1240 by 1240 pixels · wide-field fundus photograph from neonatal ROP screening.
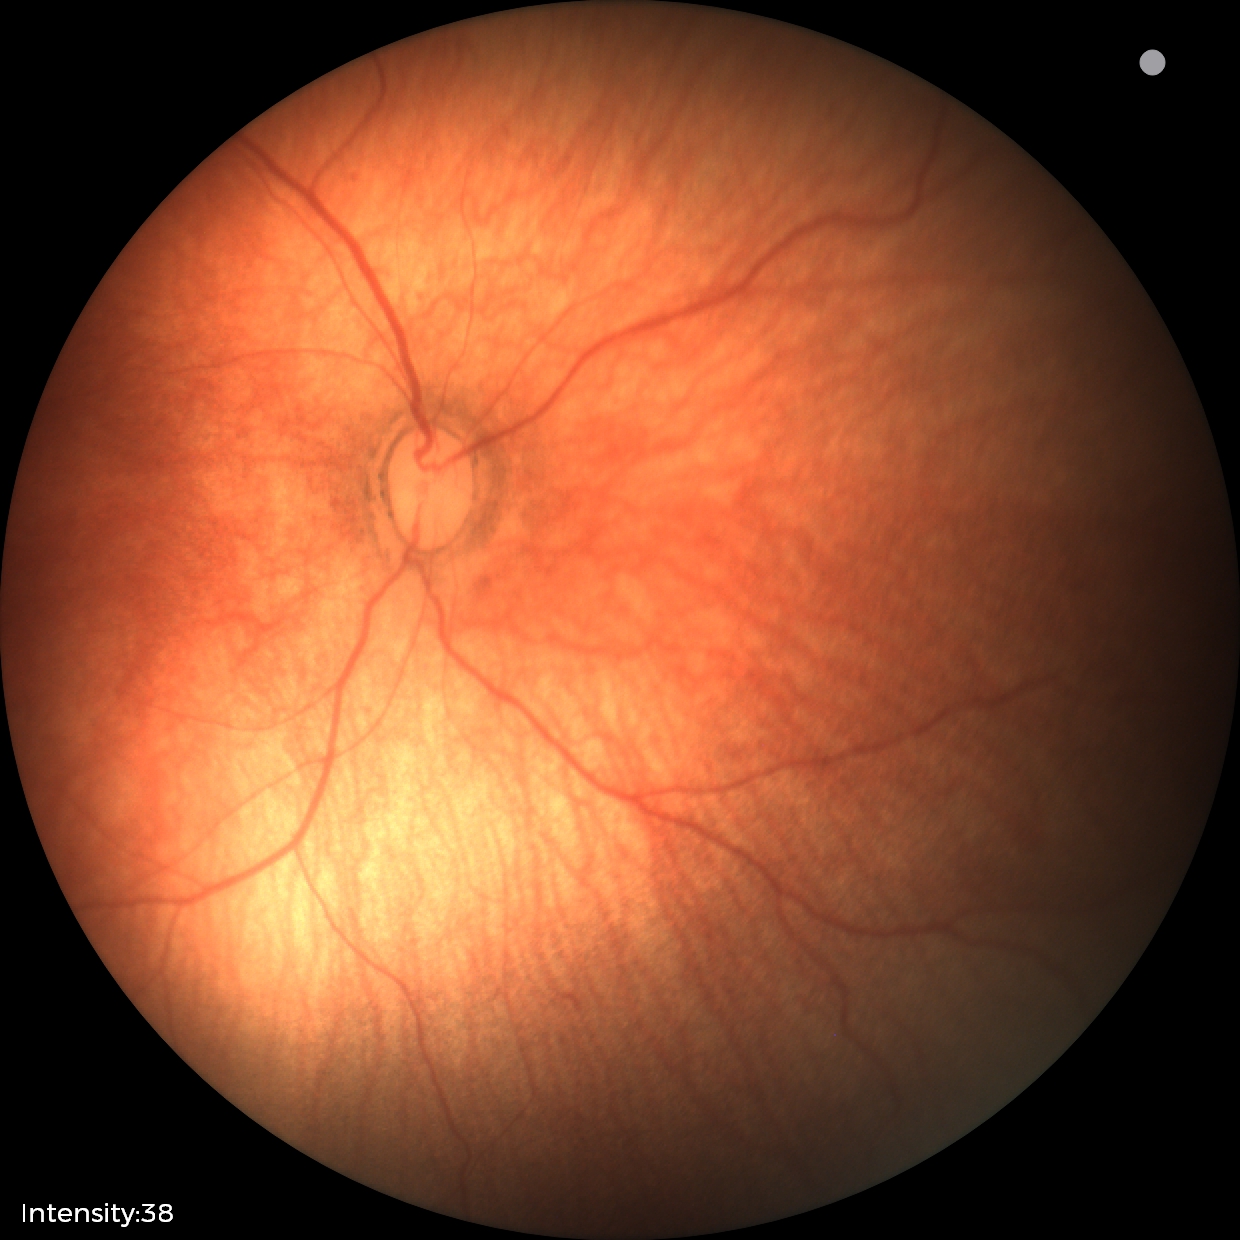

Finding: no abnormalities.